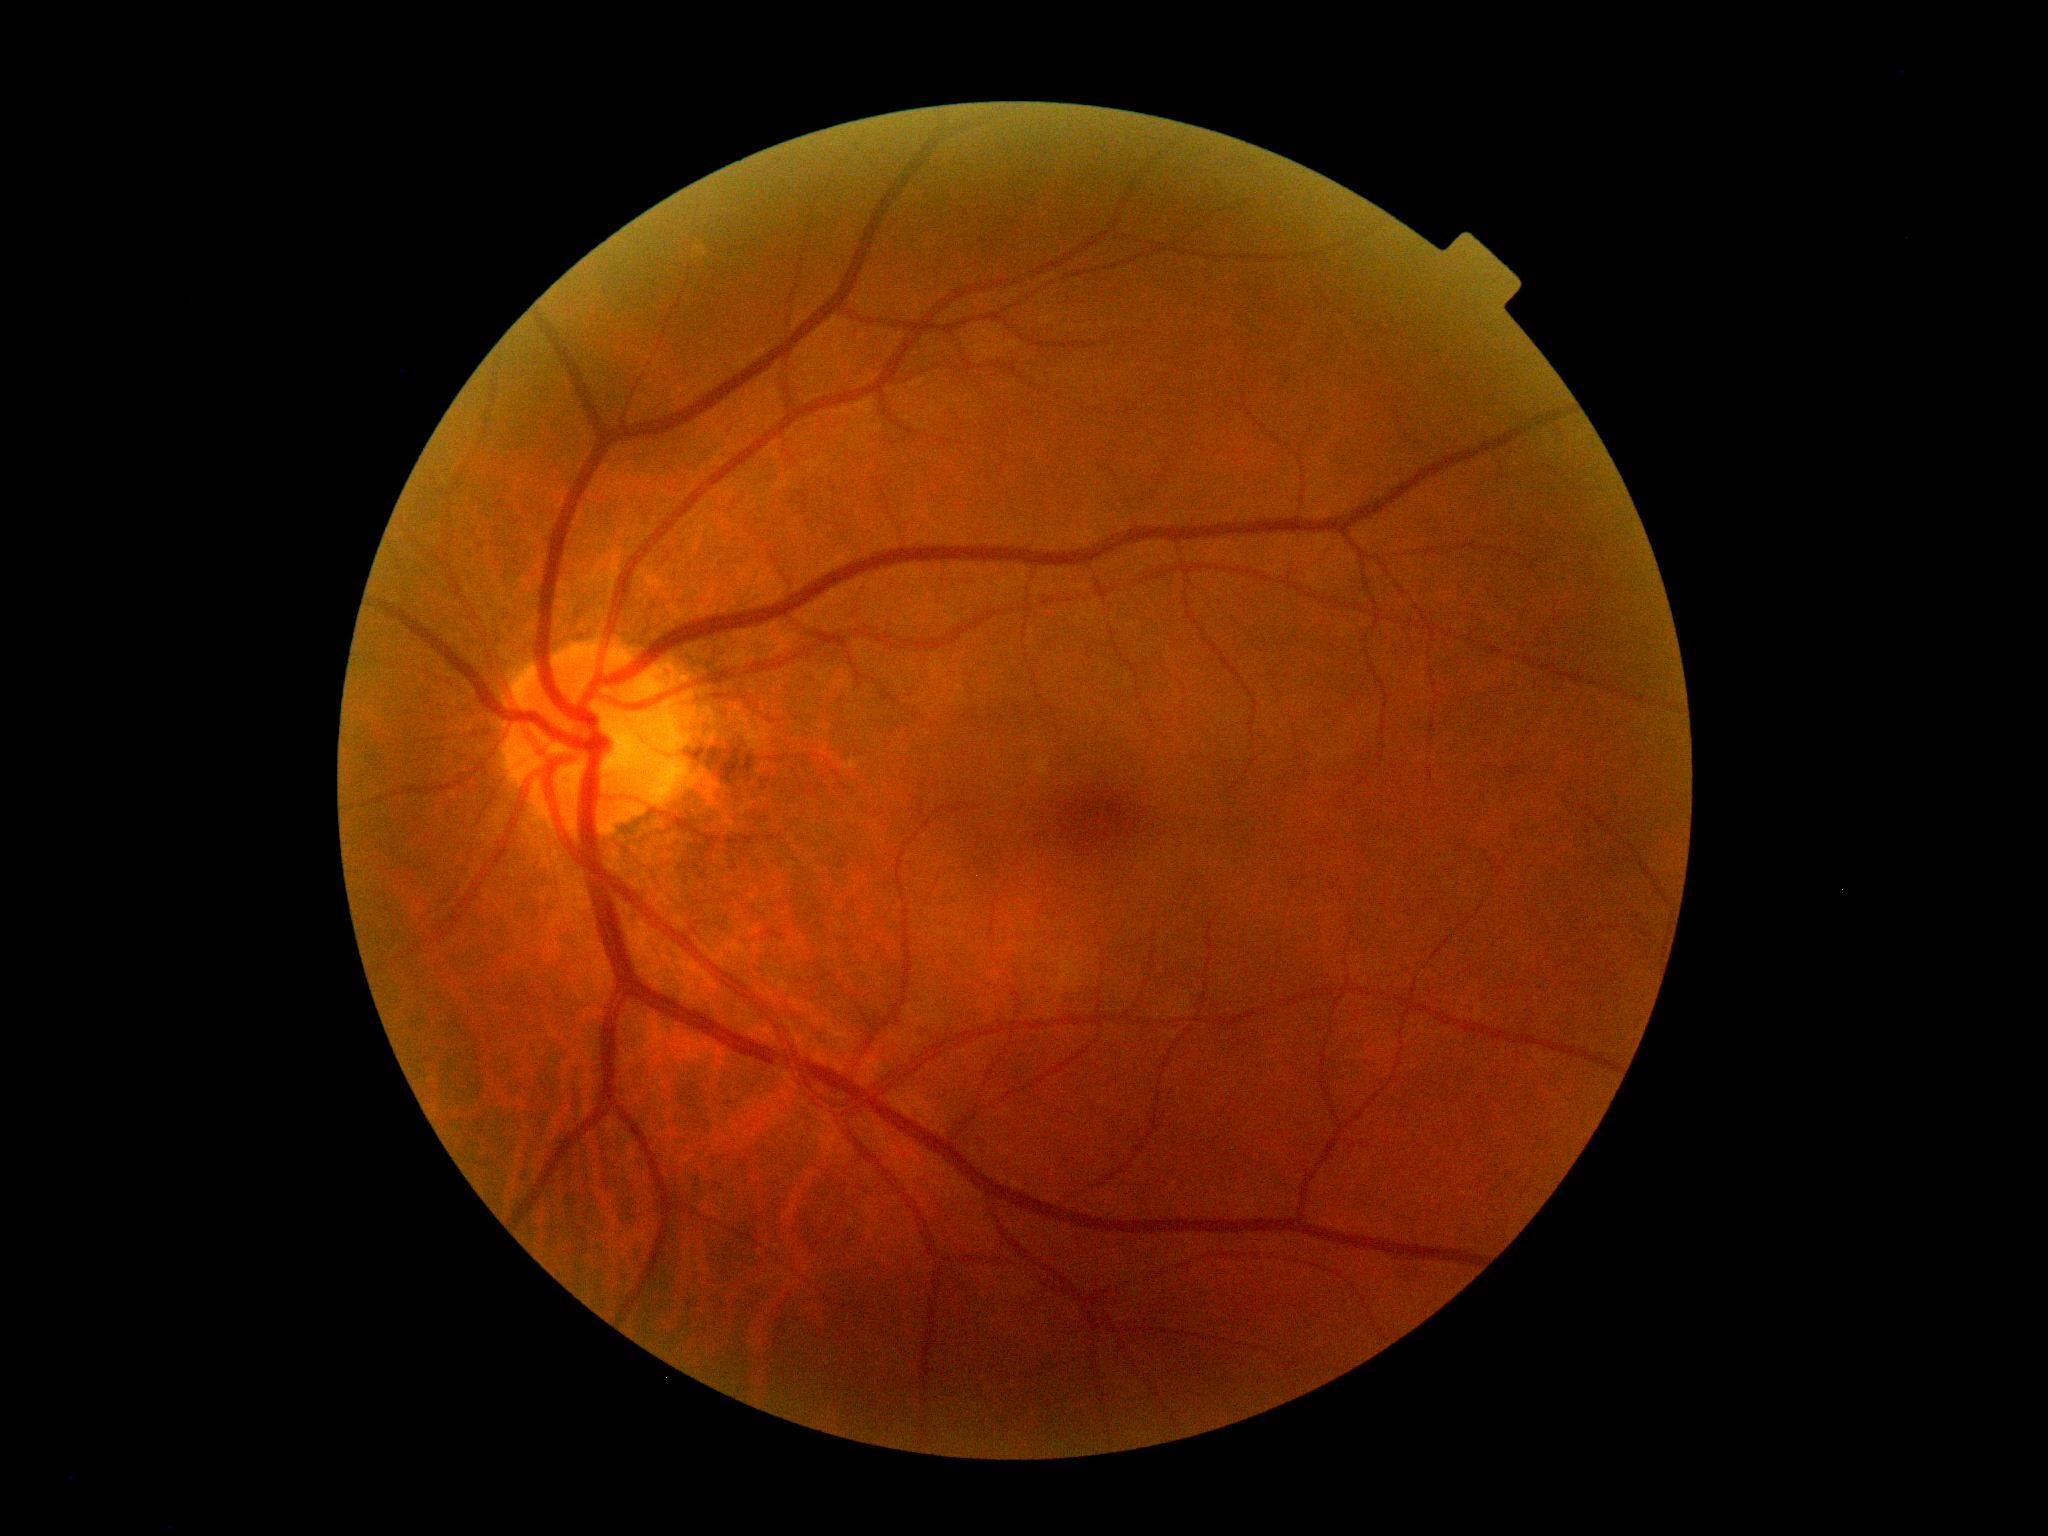
Retinopathy: 0.
No DR findings.